Color fundus image.
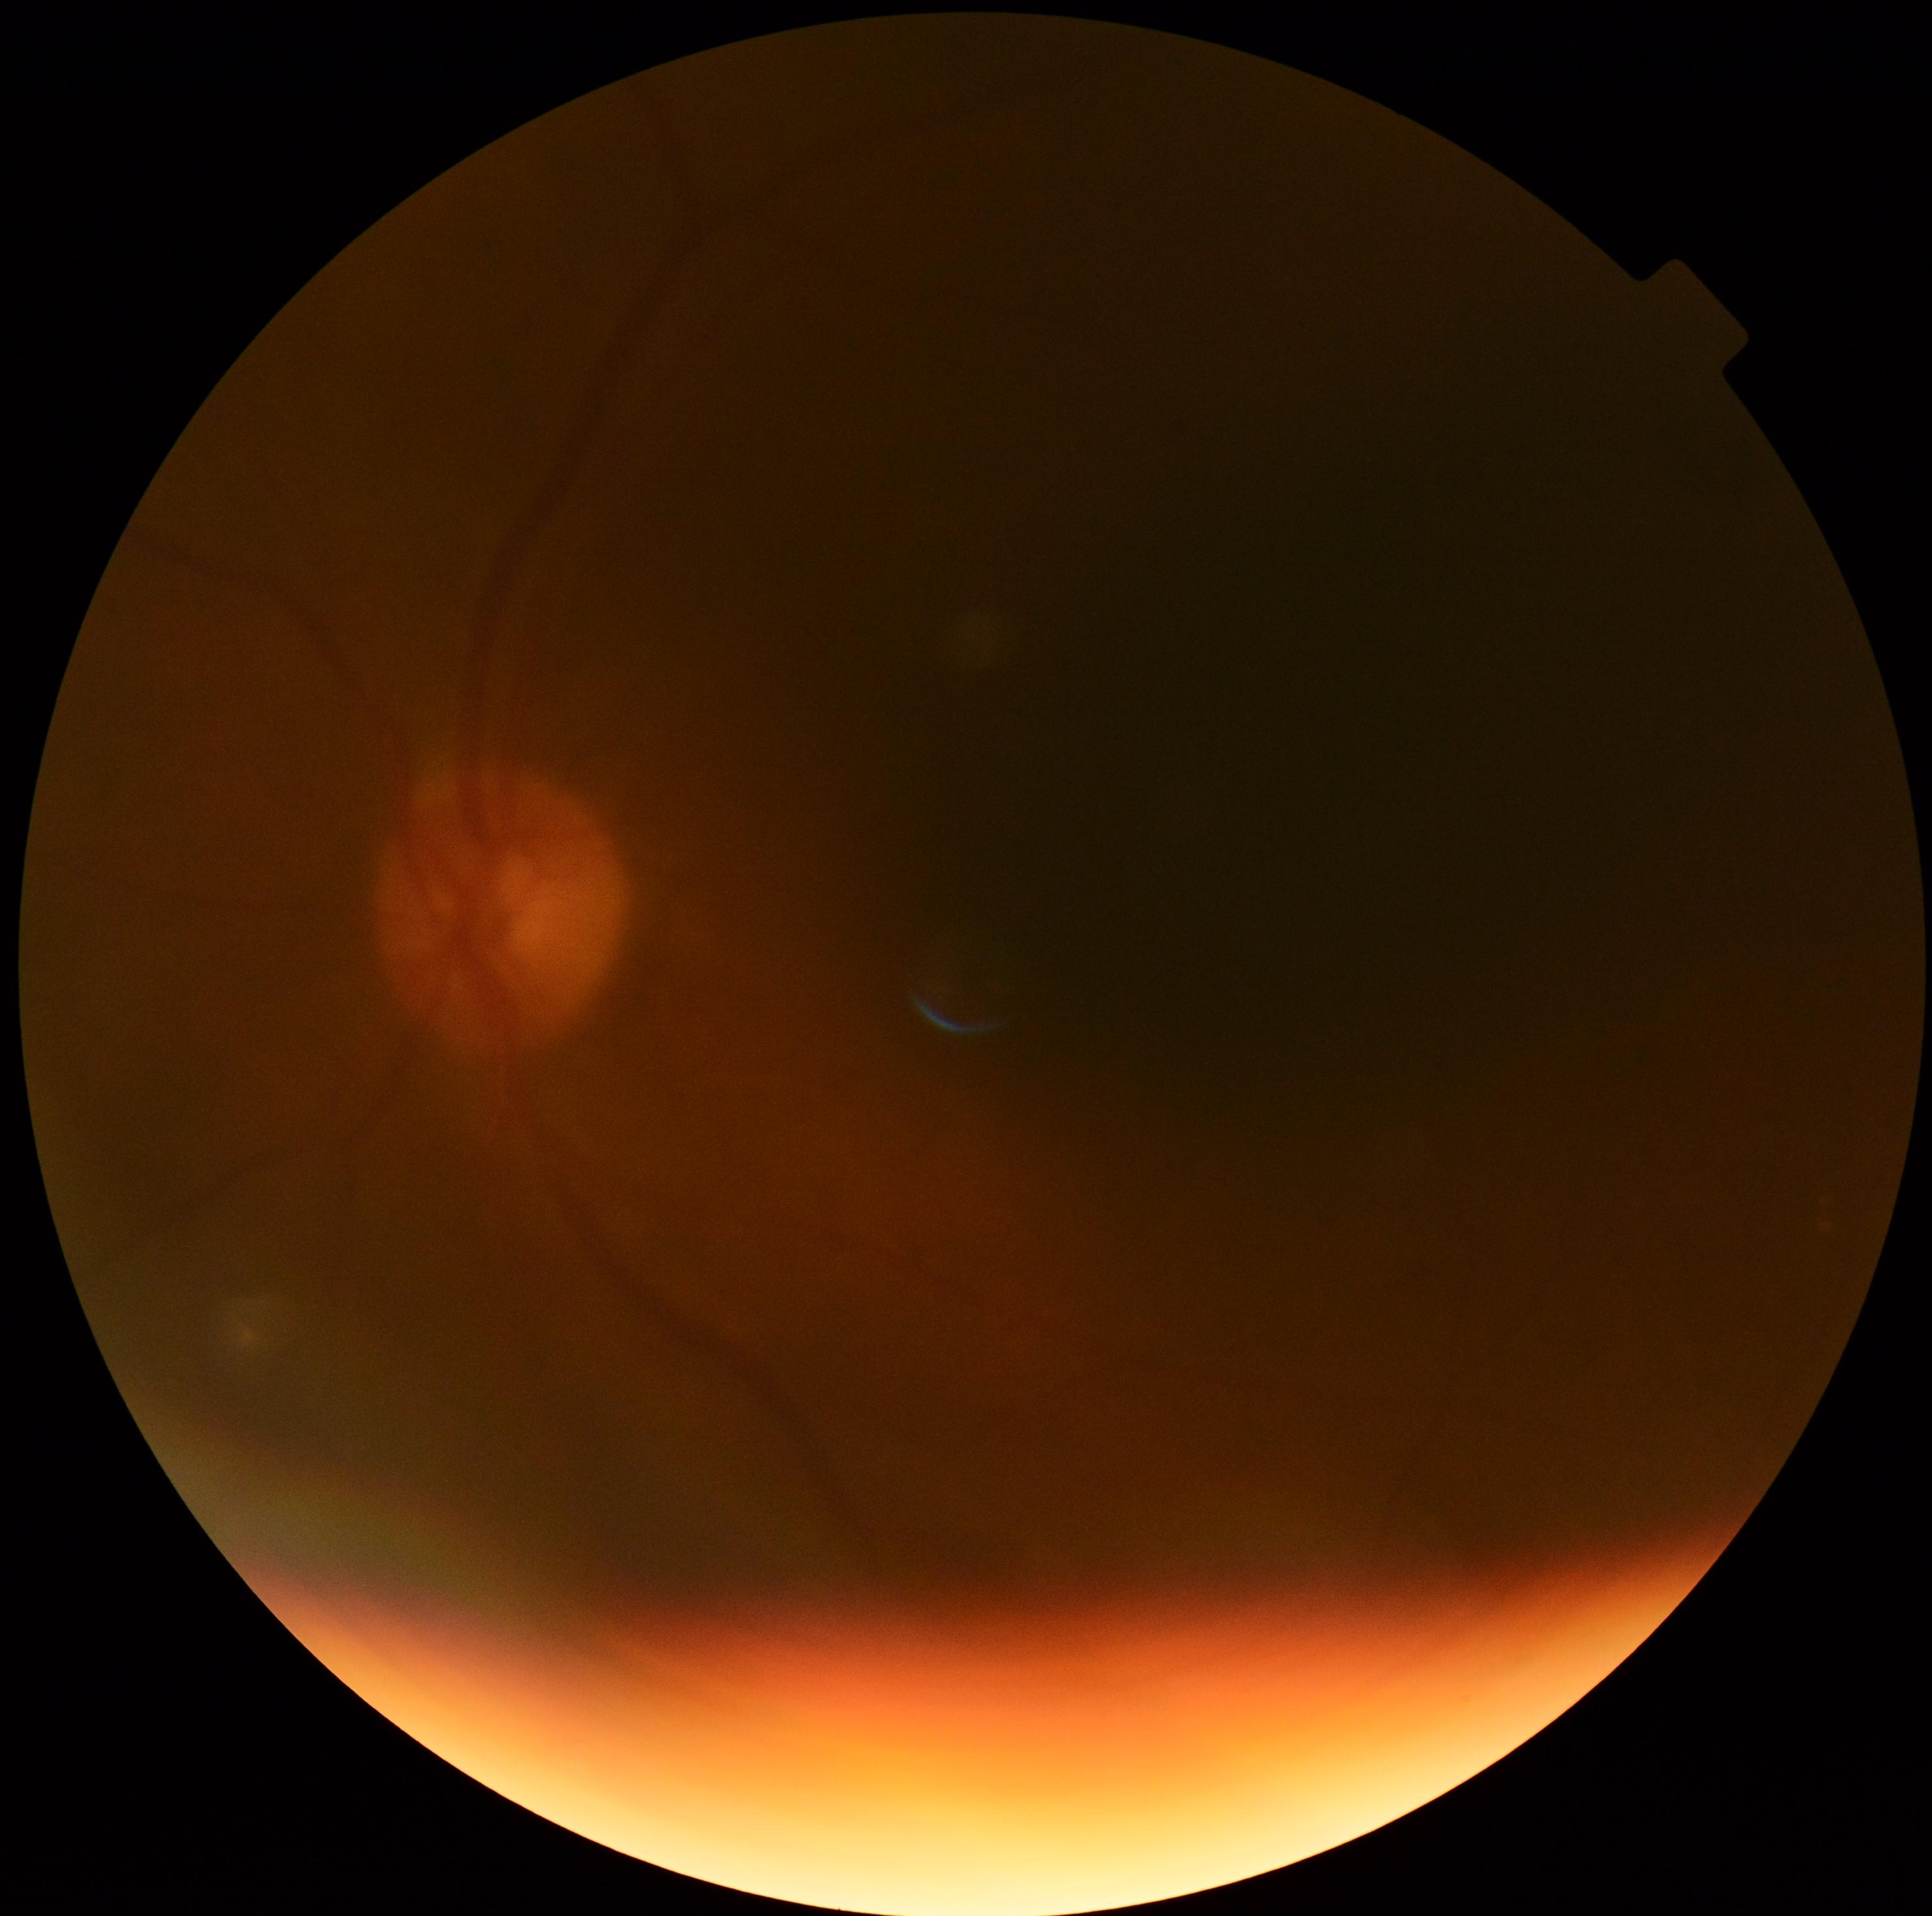

Quality too poor to assess for DR.
Diabetic retinopathy (DR) is ungradable.